FOV: 45 degrees; nonmydriatic; acquired with a NIDEK AFC-230; 848x848px:
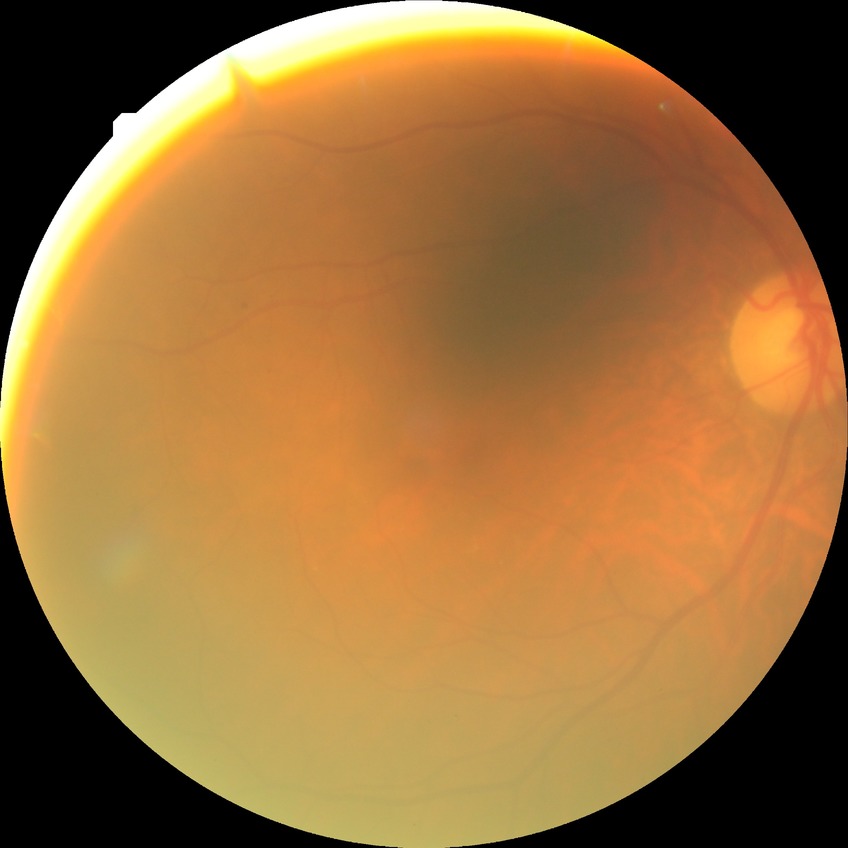

diabetic retinopathy (DR) = simple diabetic retinopathy (SDR)